50° FOV; pupil-dilated; camera: Kowa VX-10α:
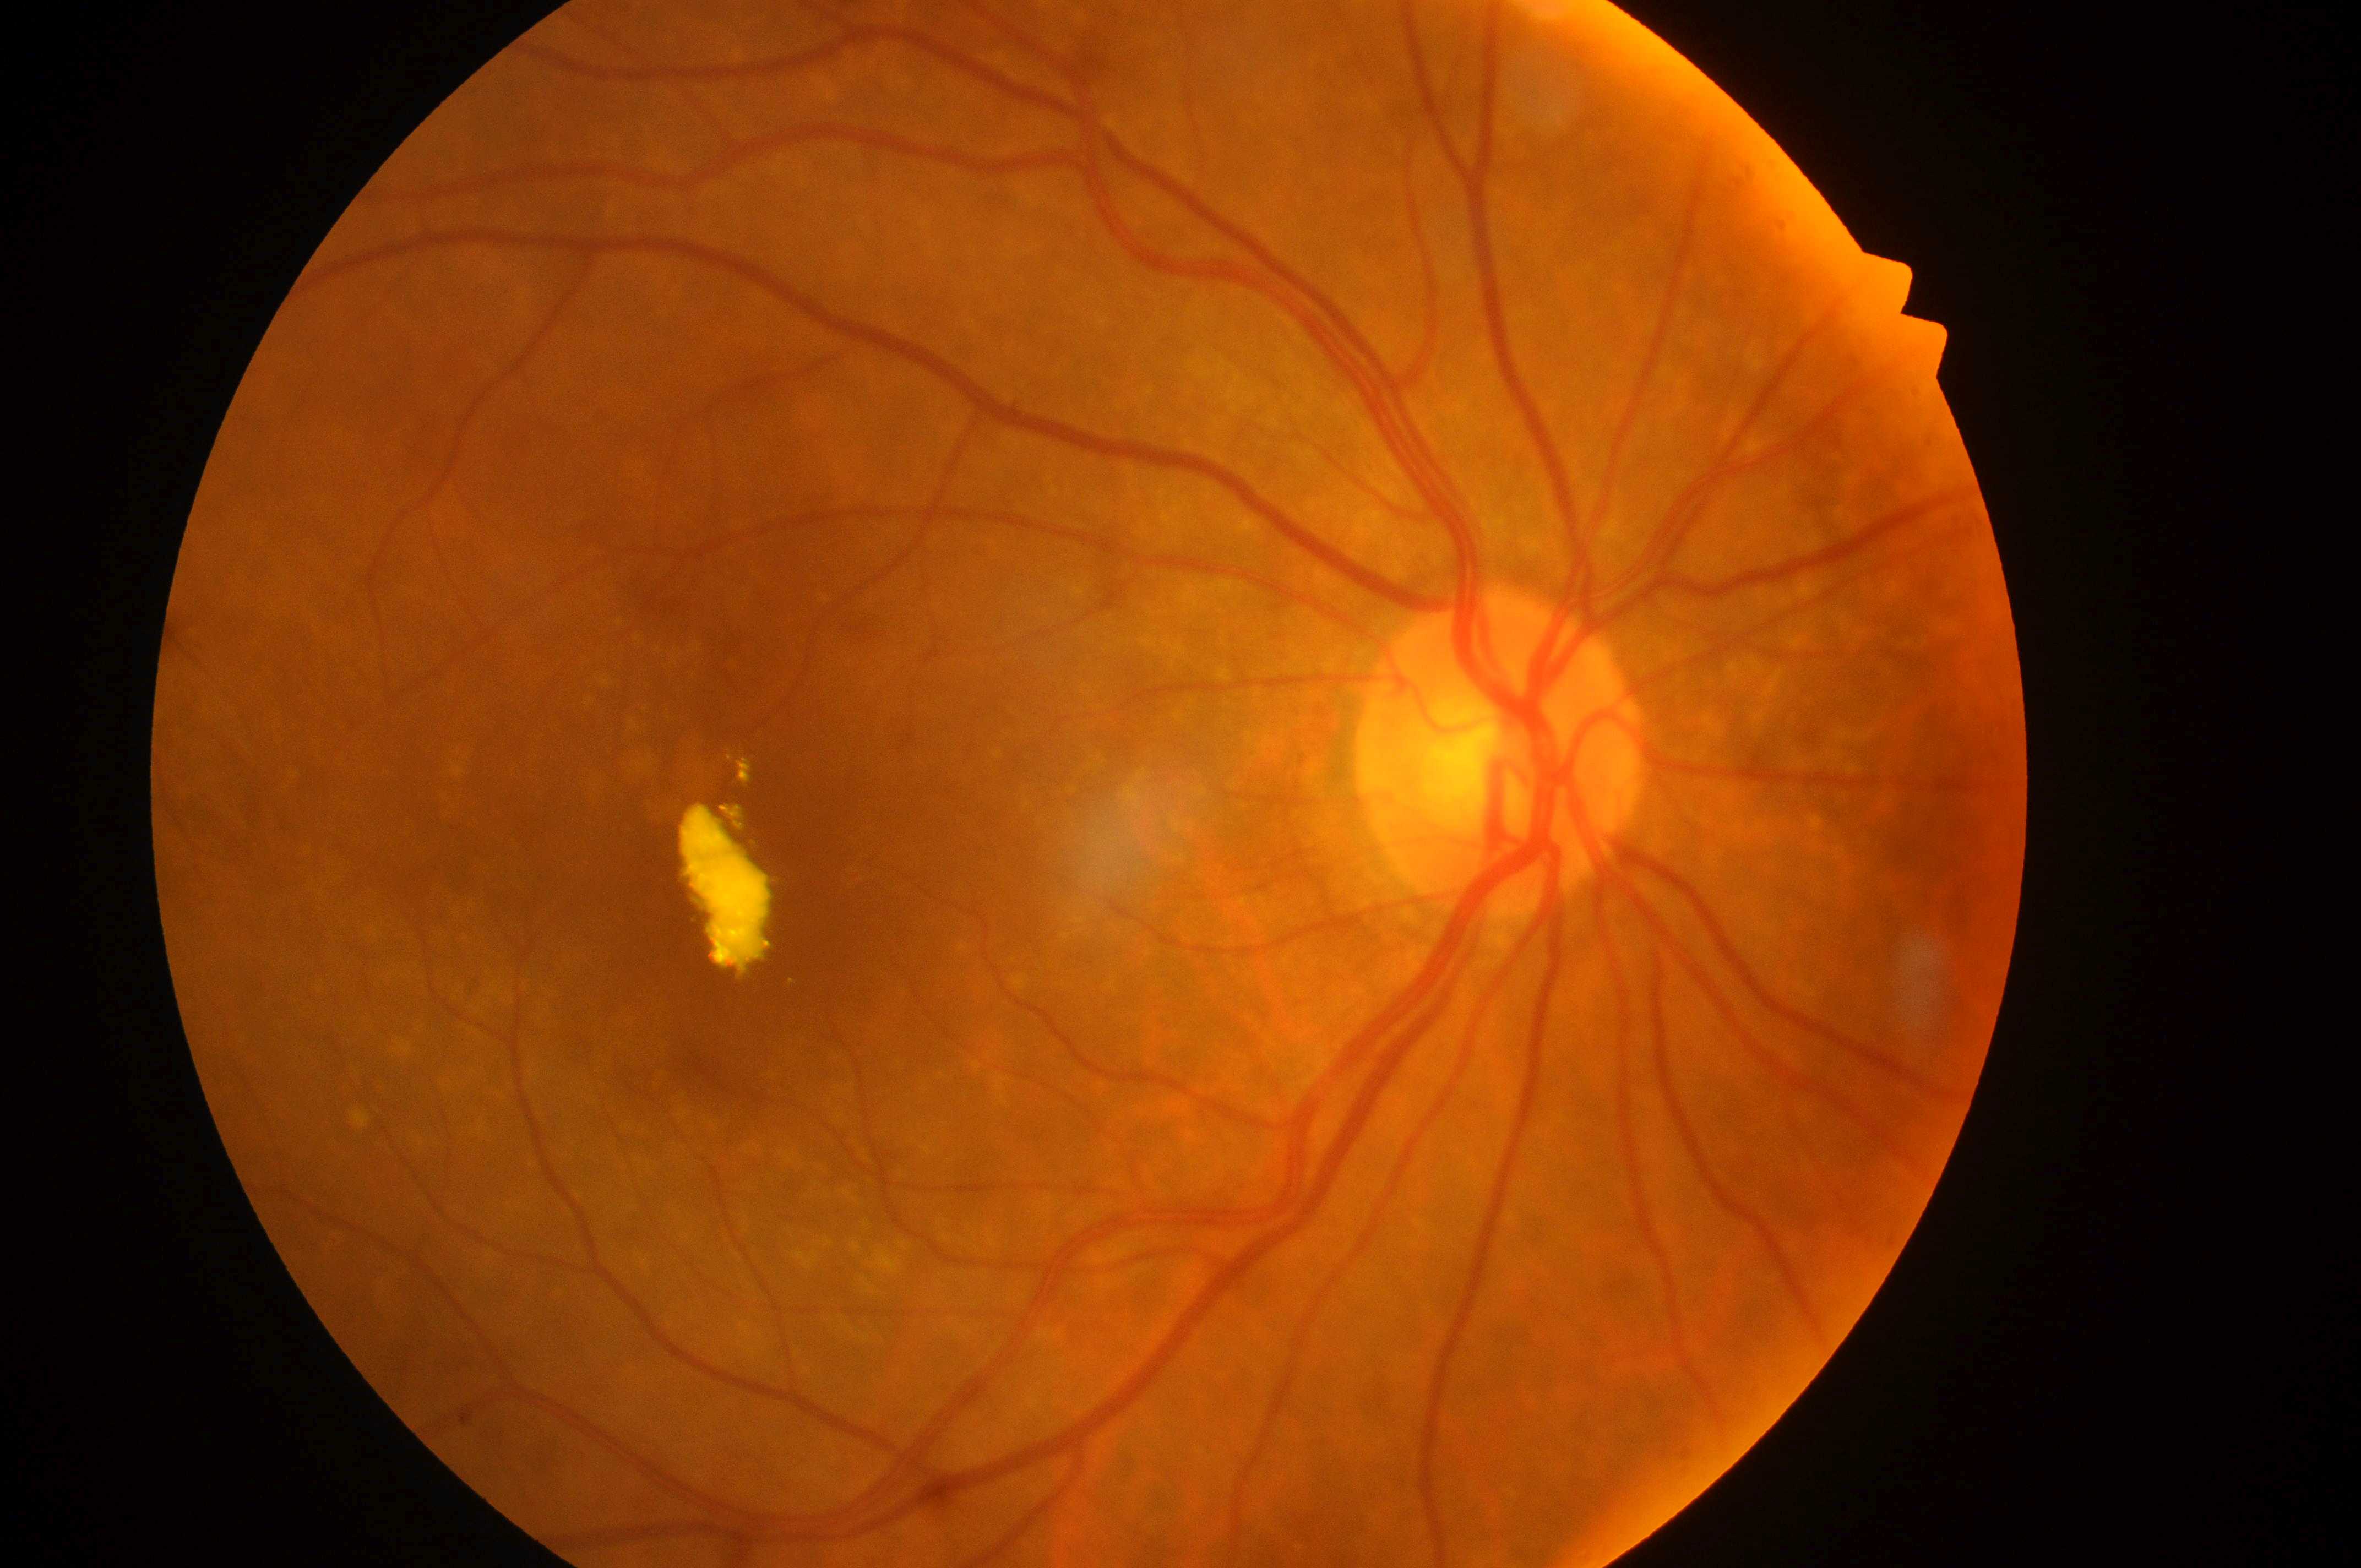 – laterality: right
– fovea centralis: 736, 897
– DR class: non-proliferative diabetic retinopathy
– DR: 2/4
– optic disk: 1498, 763
– DME: grade 2